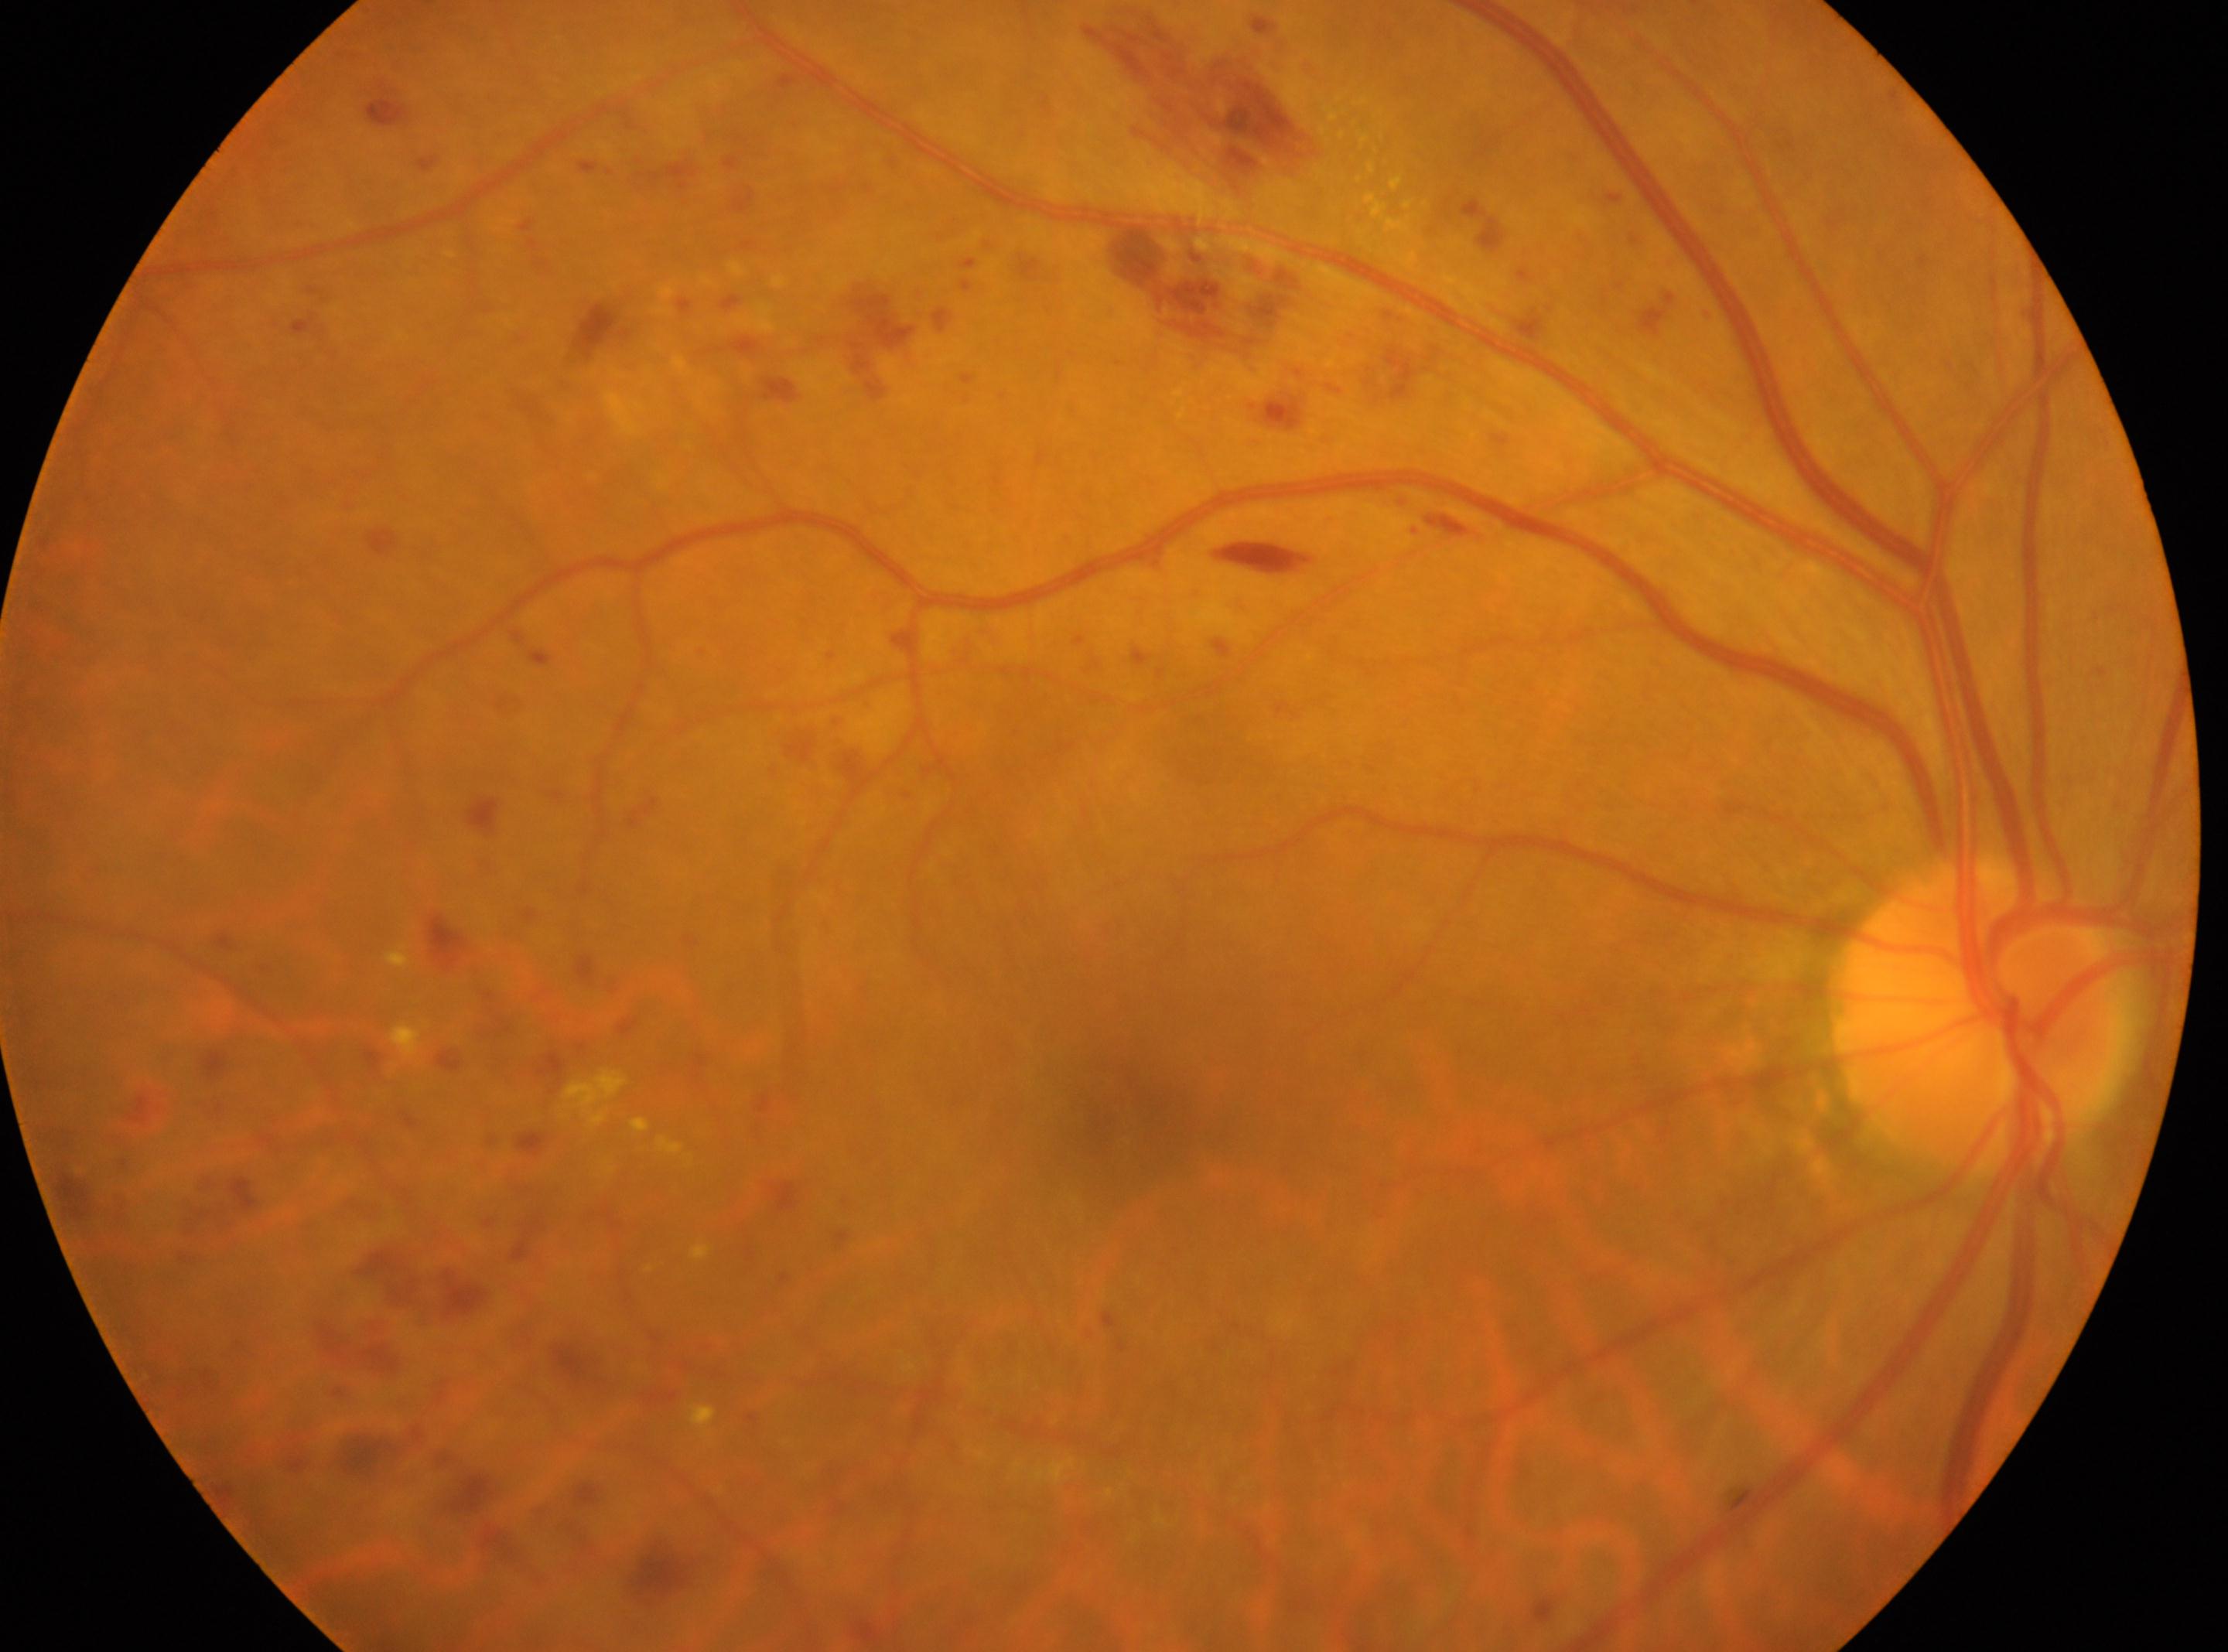

{
  "optic_disc": "(1975,1015)",
  "eye": "right",
  "fovea": "(1120,1109)",
  "dr_category": "proliferative diabetic retinopathy",
  "dr_grade": "4/4"
}